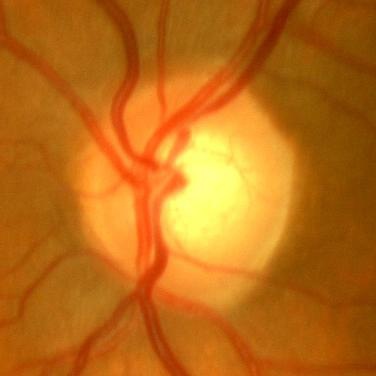
No glaucomatous optic neuropathy.